Corneal thickness 527 µm; color fundus photograph; captured without pupil dilation; image size 2212x1661; axial length 22.63 mm; intraocular pressure: 16 mmHg; refractive error: +5 -2 × 85°; FOV: 30 degrees; Topcon TRC-NW400 — 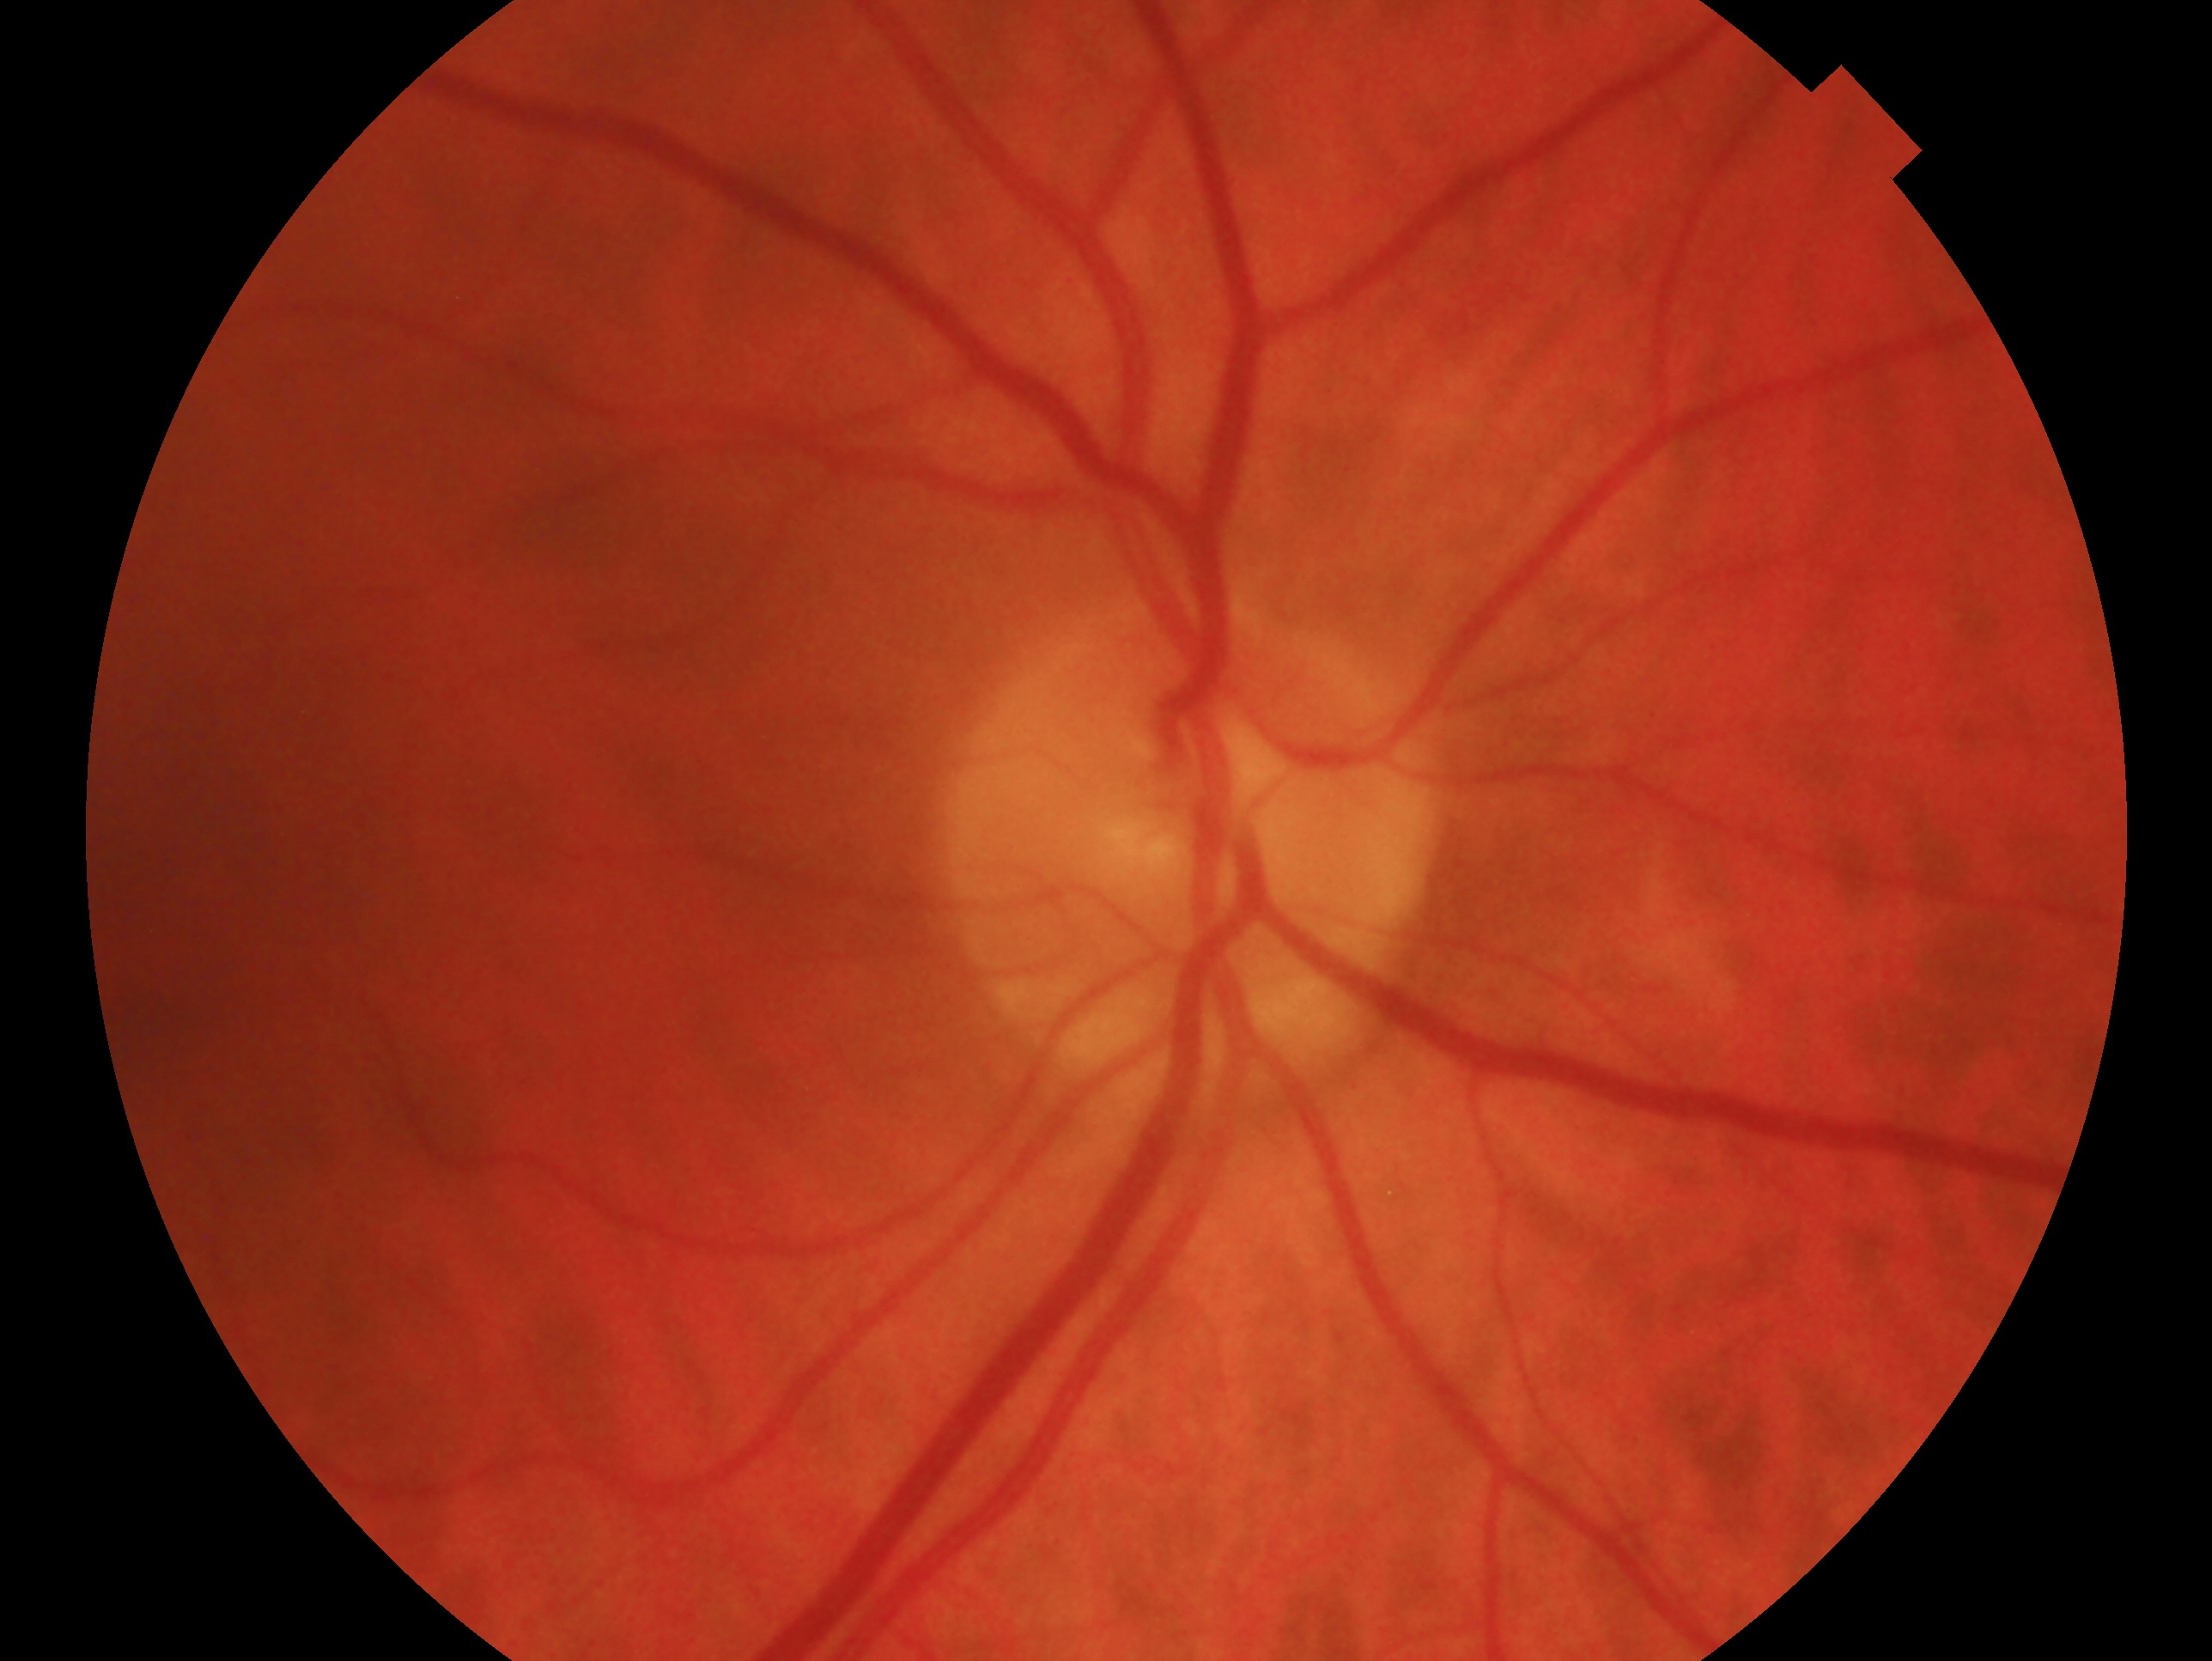
diagnosis: no evidence of glaucoma; laterality: right eye.